Pediatric retinal photograph (wide-field): 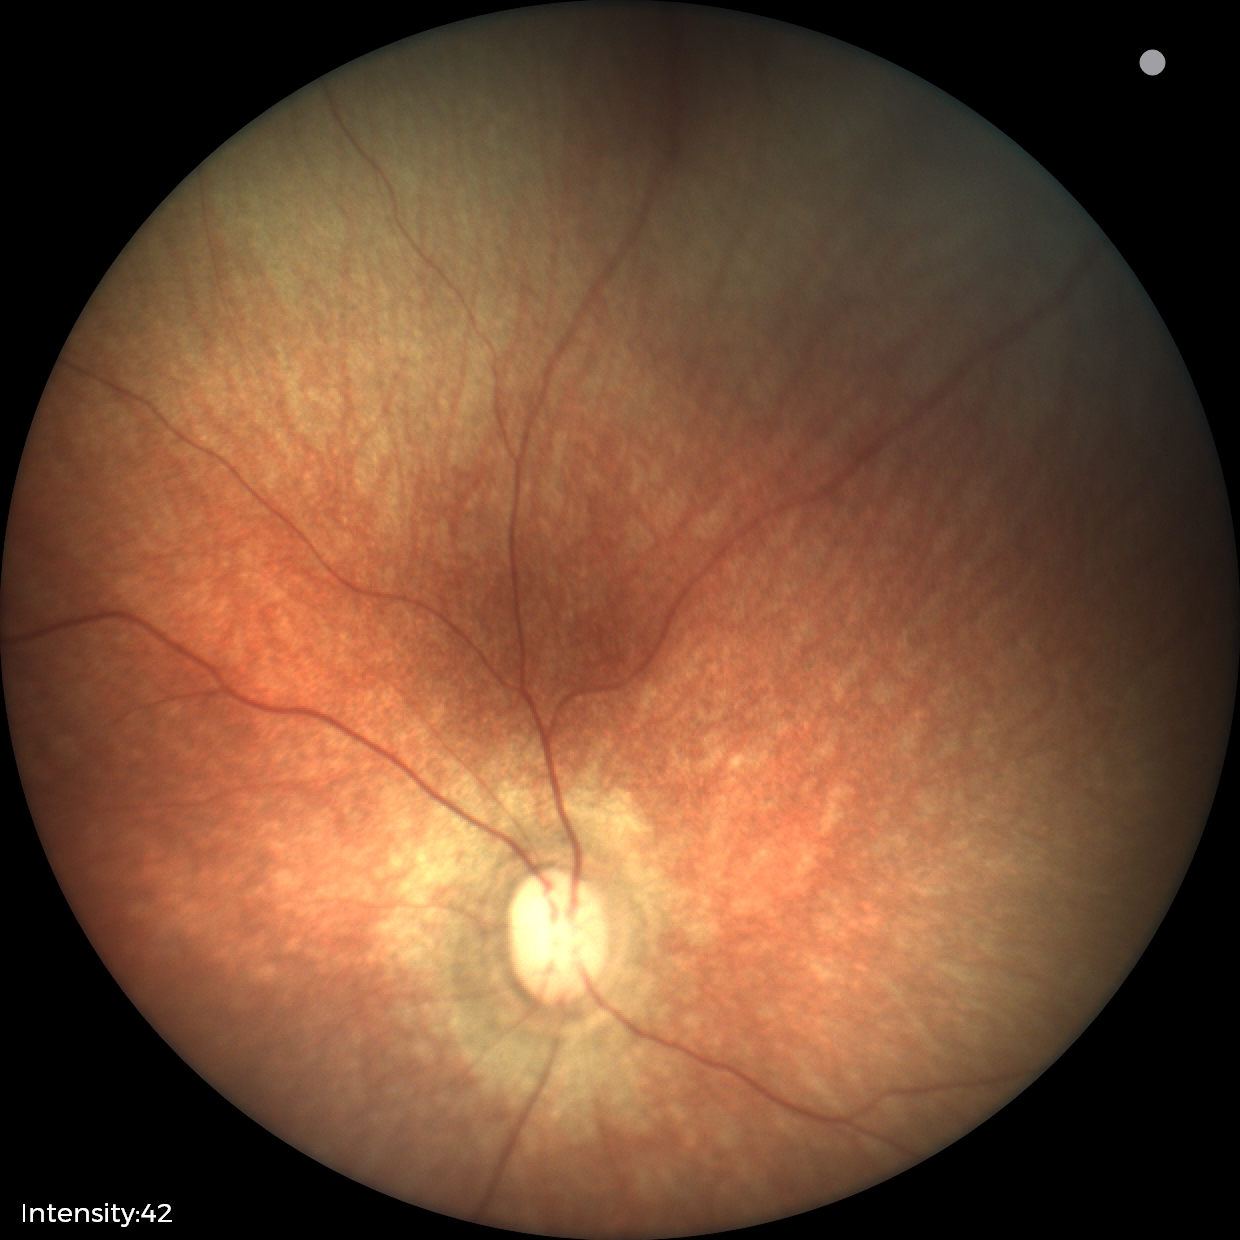 No retinal pathology identified on screening.